Pediatric wide-field fundus photograph; captured with the Natus RetCam Envision (130° field of view); 1440x1080.
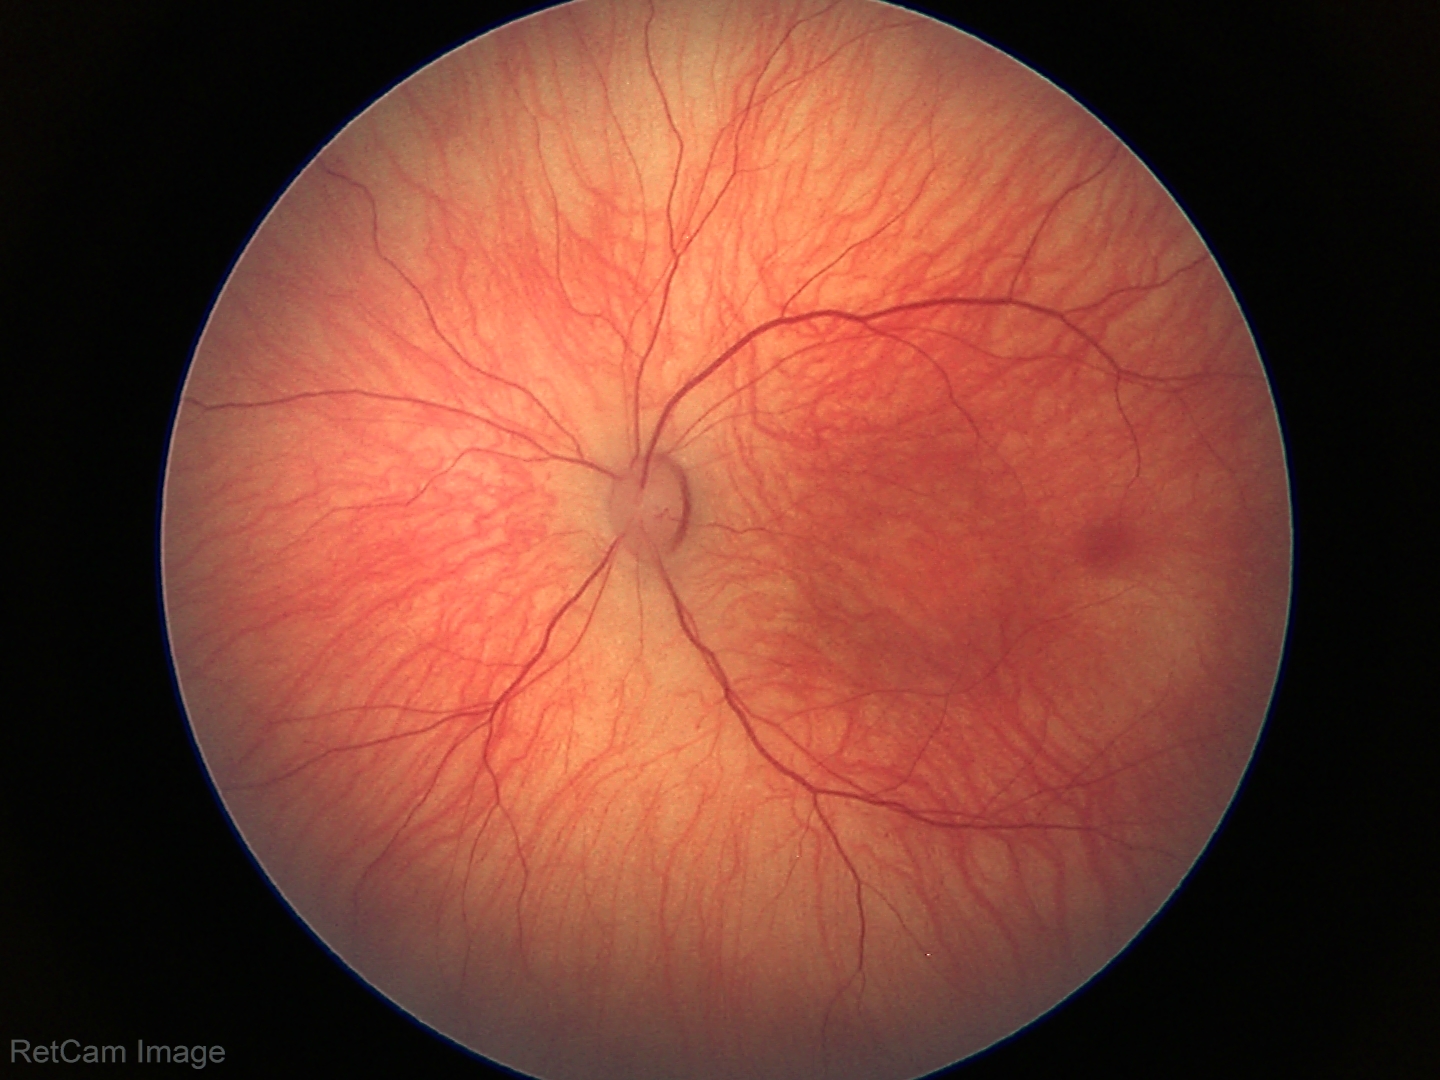 Screening: physiological finding.